FOV: 45 degrees — 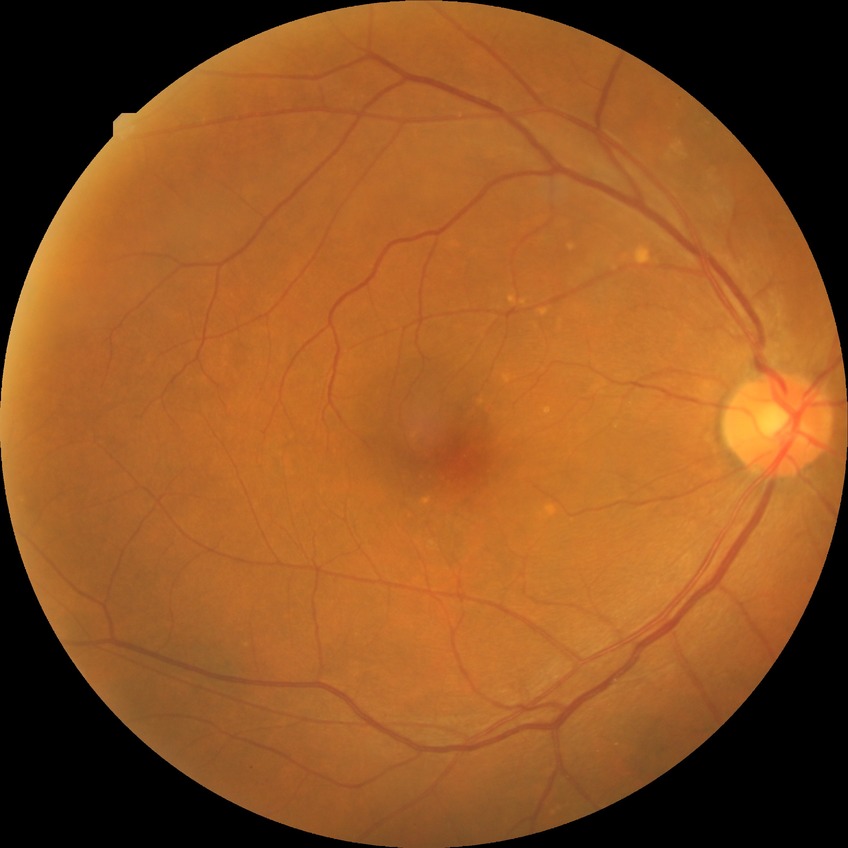 {"davis_grade": "NDR (no diabetic retinopathy)"}